Wide-field fundus photograph of an infant — 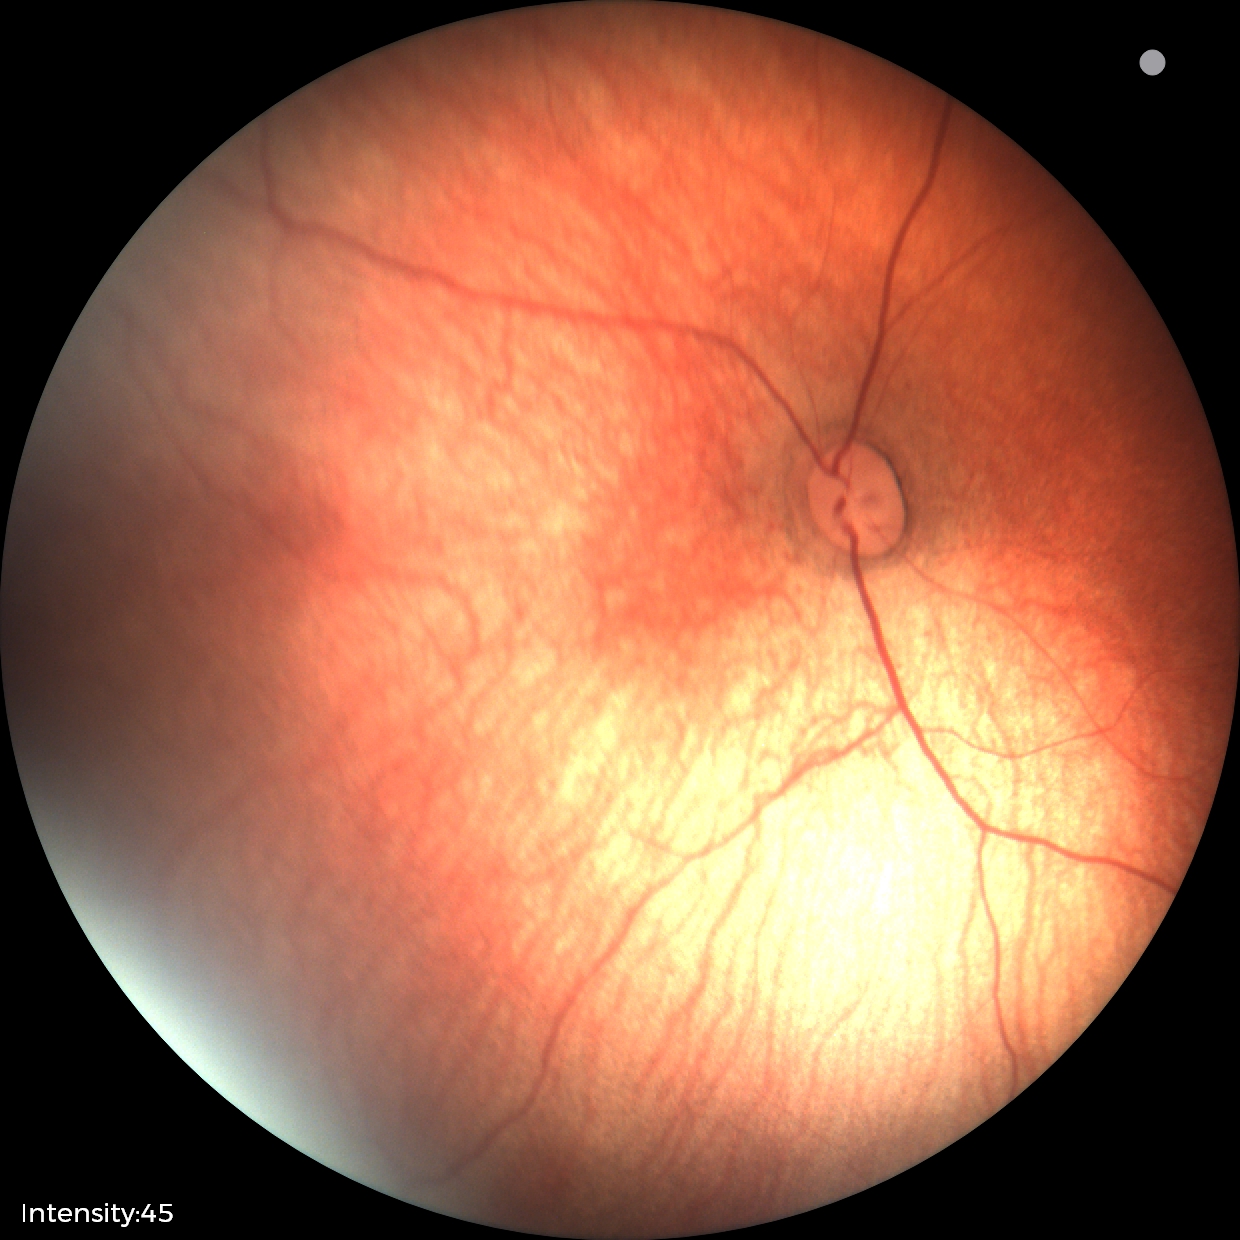

No retinal pathology identified on screening.